Acquired with a NIDEK AFC-230 · graded on the modified Davis scale · FOV: 45 degrees
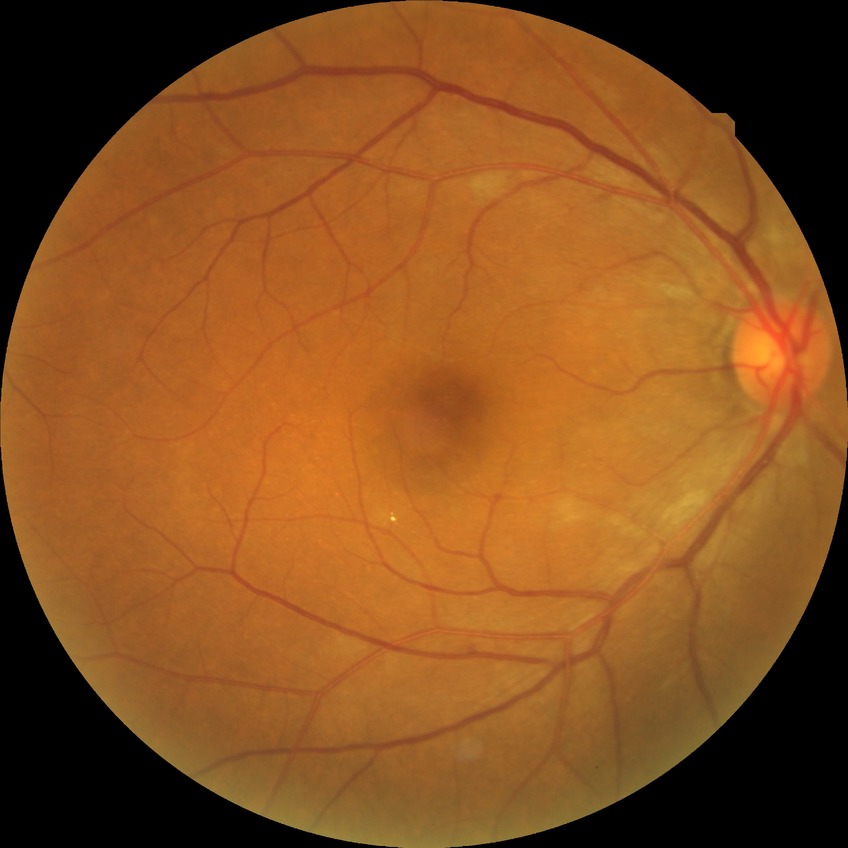

Davis DR grade: NDR.